Captured on a Bosch handheld camera, retinal fundus photograph
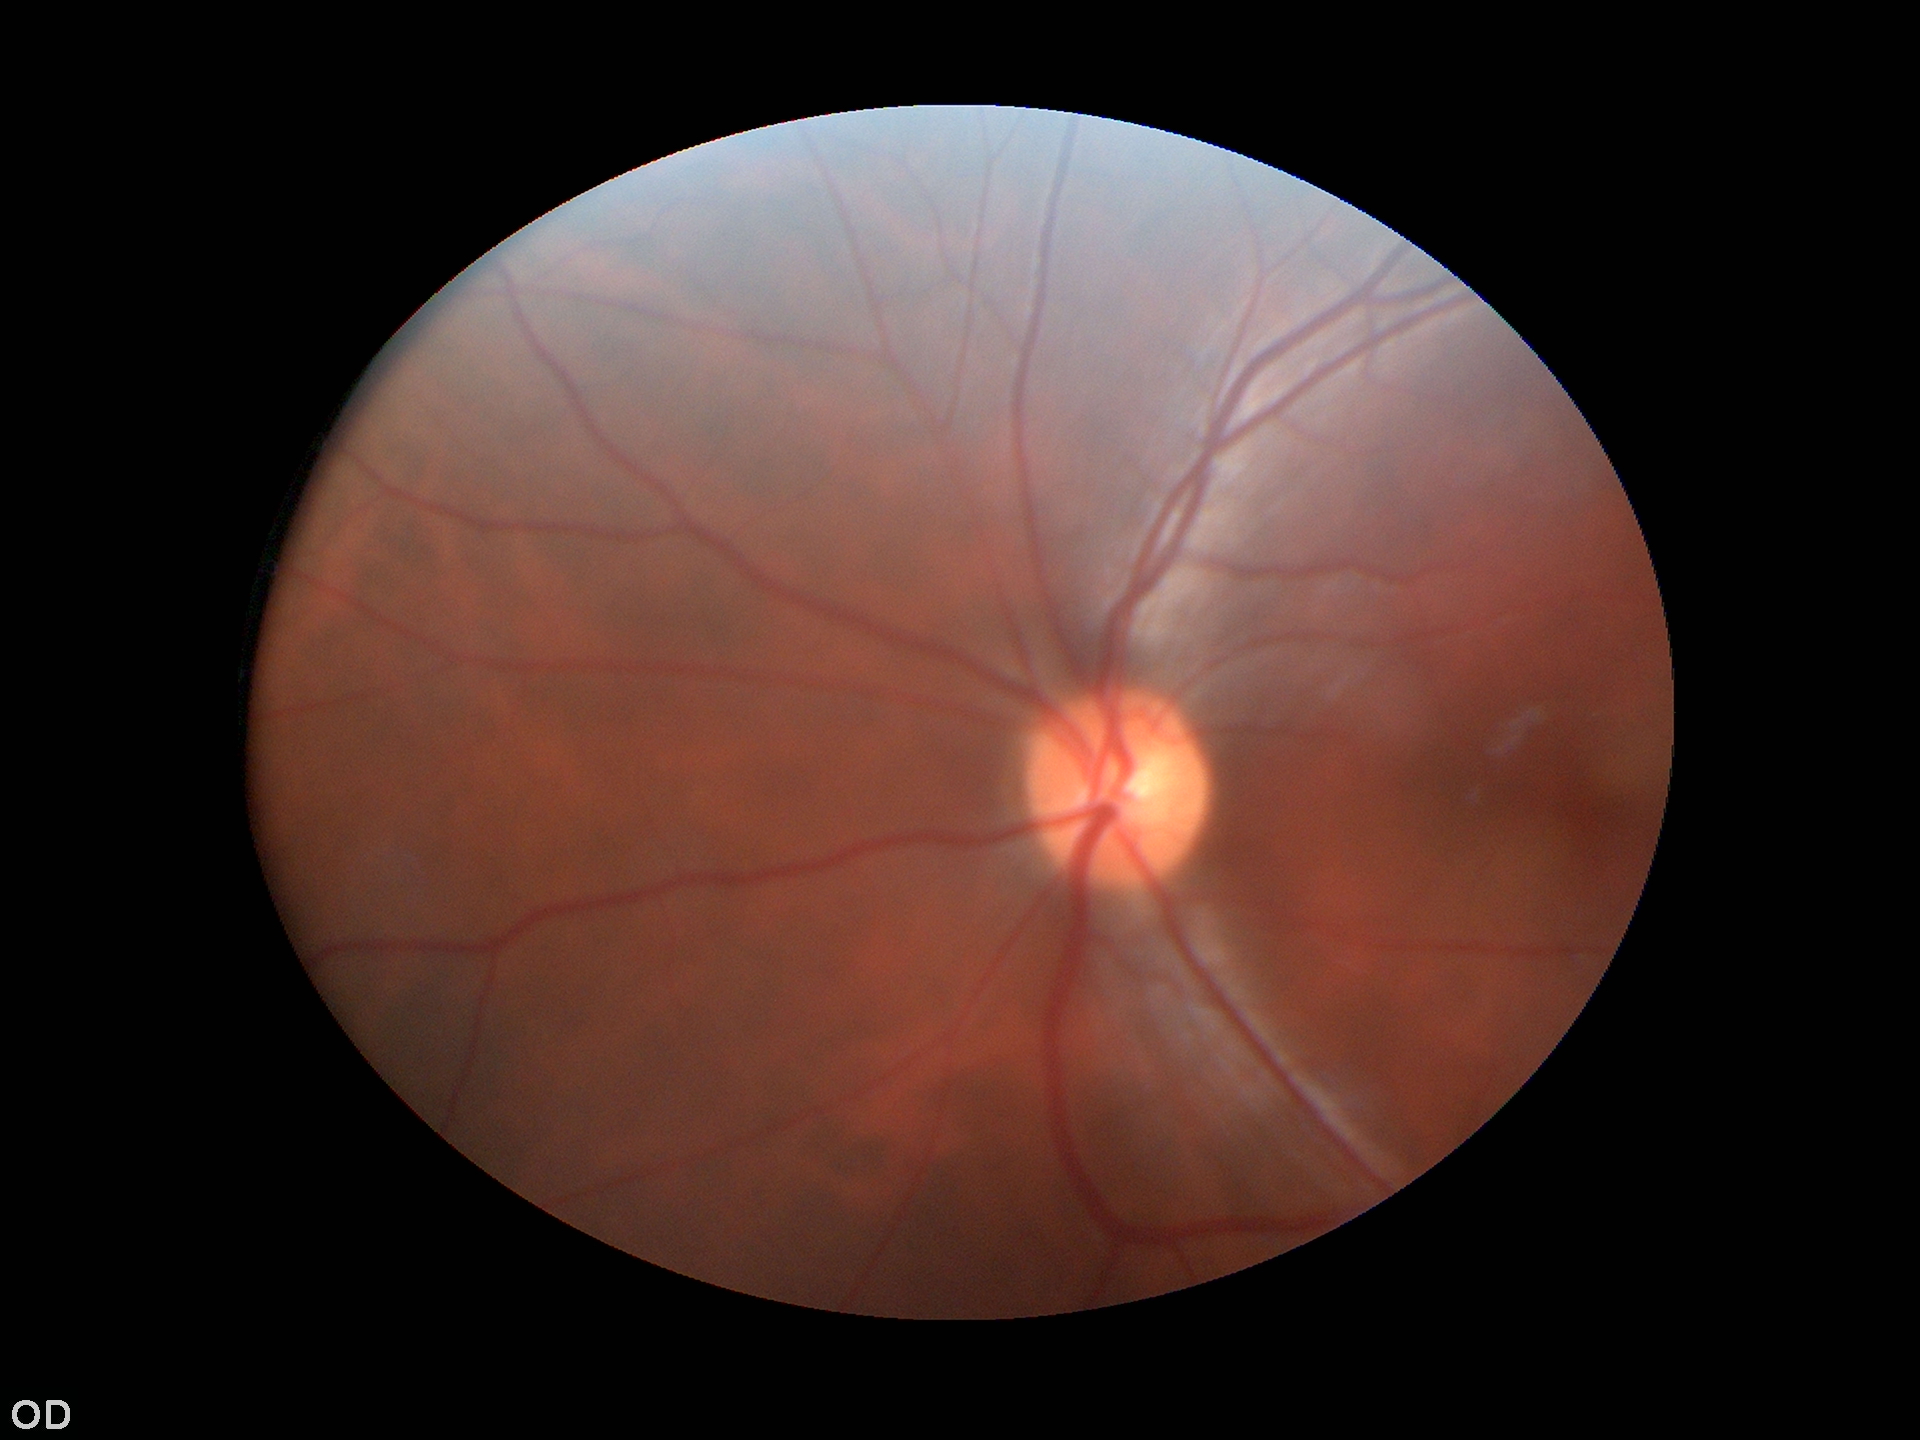
Glaucoma evaluation: no suspicious findings (5/5 ophthalmologists in agreement).
HCDR of 0.49.
ACDR of 0.24.
VCDR is 0.49.